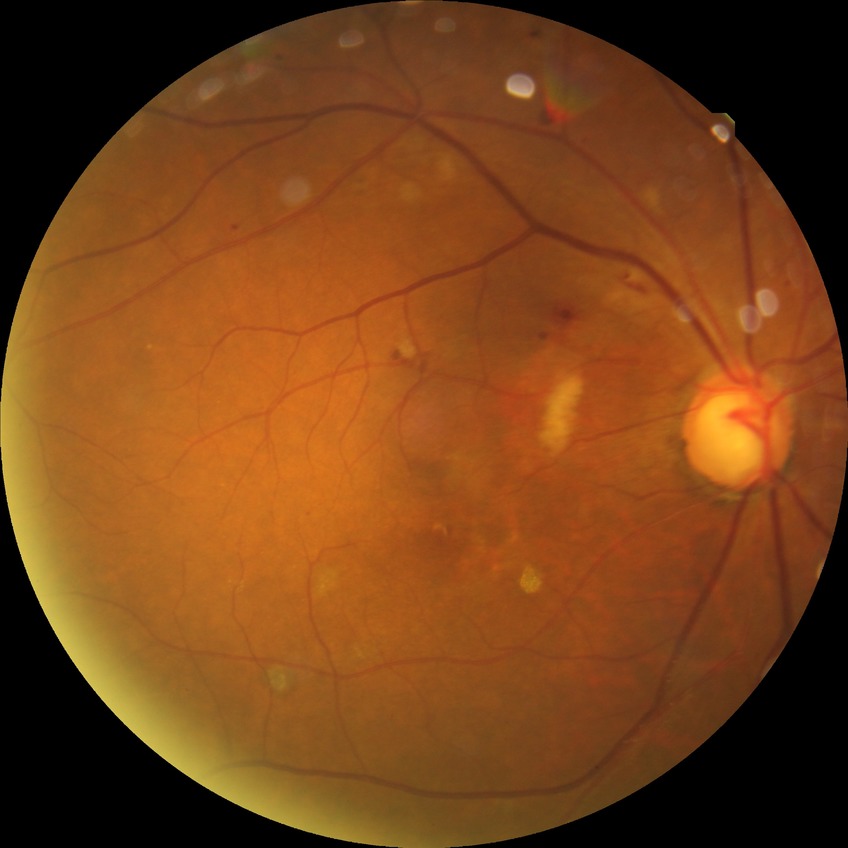

Diabetic retinopathy (DR) is PPDR (pre-proliferative diabetic retinopathy). DR class: non-proliferative diabetic retinopathy.